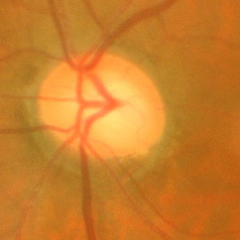
Assessment = early glaucomatous changes. (Criteria: glaucomatous retinal nerve fiber layer defects on red-free fundus photography without visual field defects.)